DR severity per modified Davis staging · posterior pole photograph.
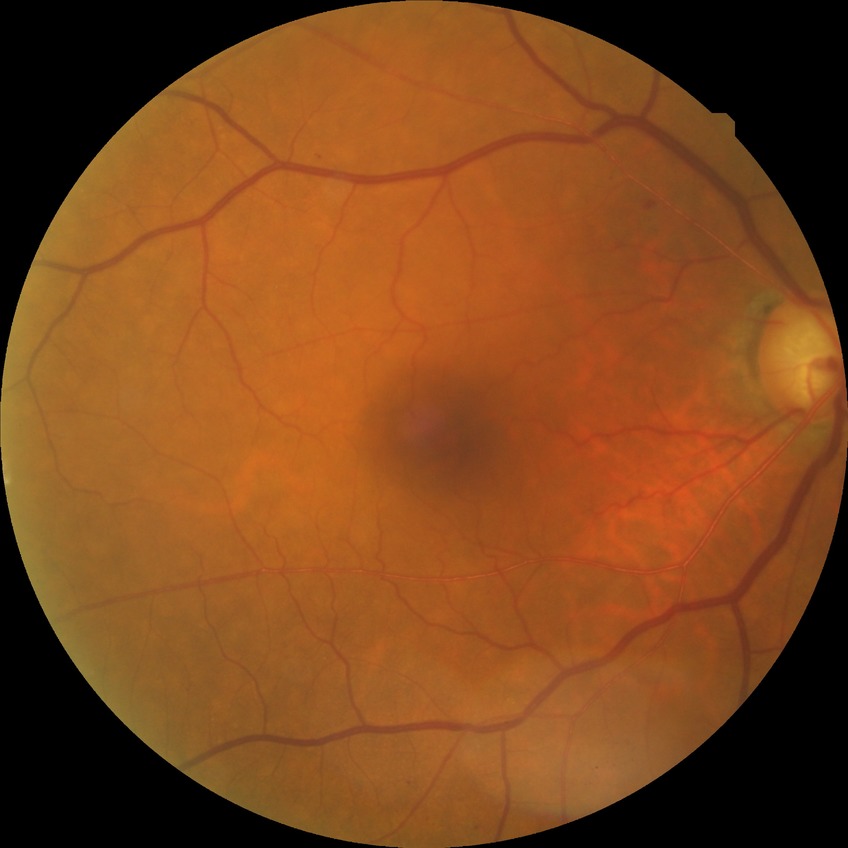

No signs of diabetic retinopathy. Davis stage: NDR.